Image size 640x480. Wide-field contact fundus photograph of an infant.
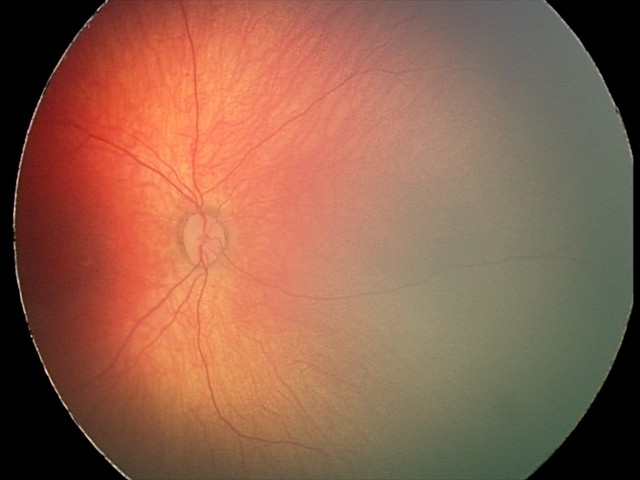 Screening examination diagnosed as physiological.